1470x1137
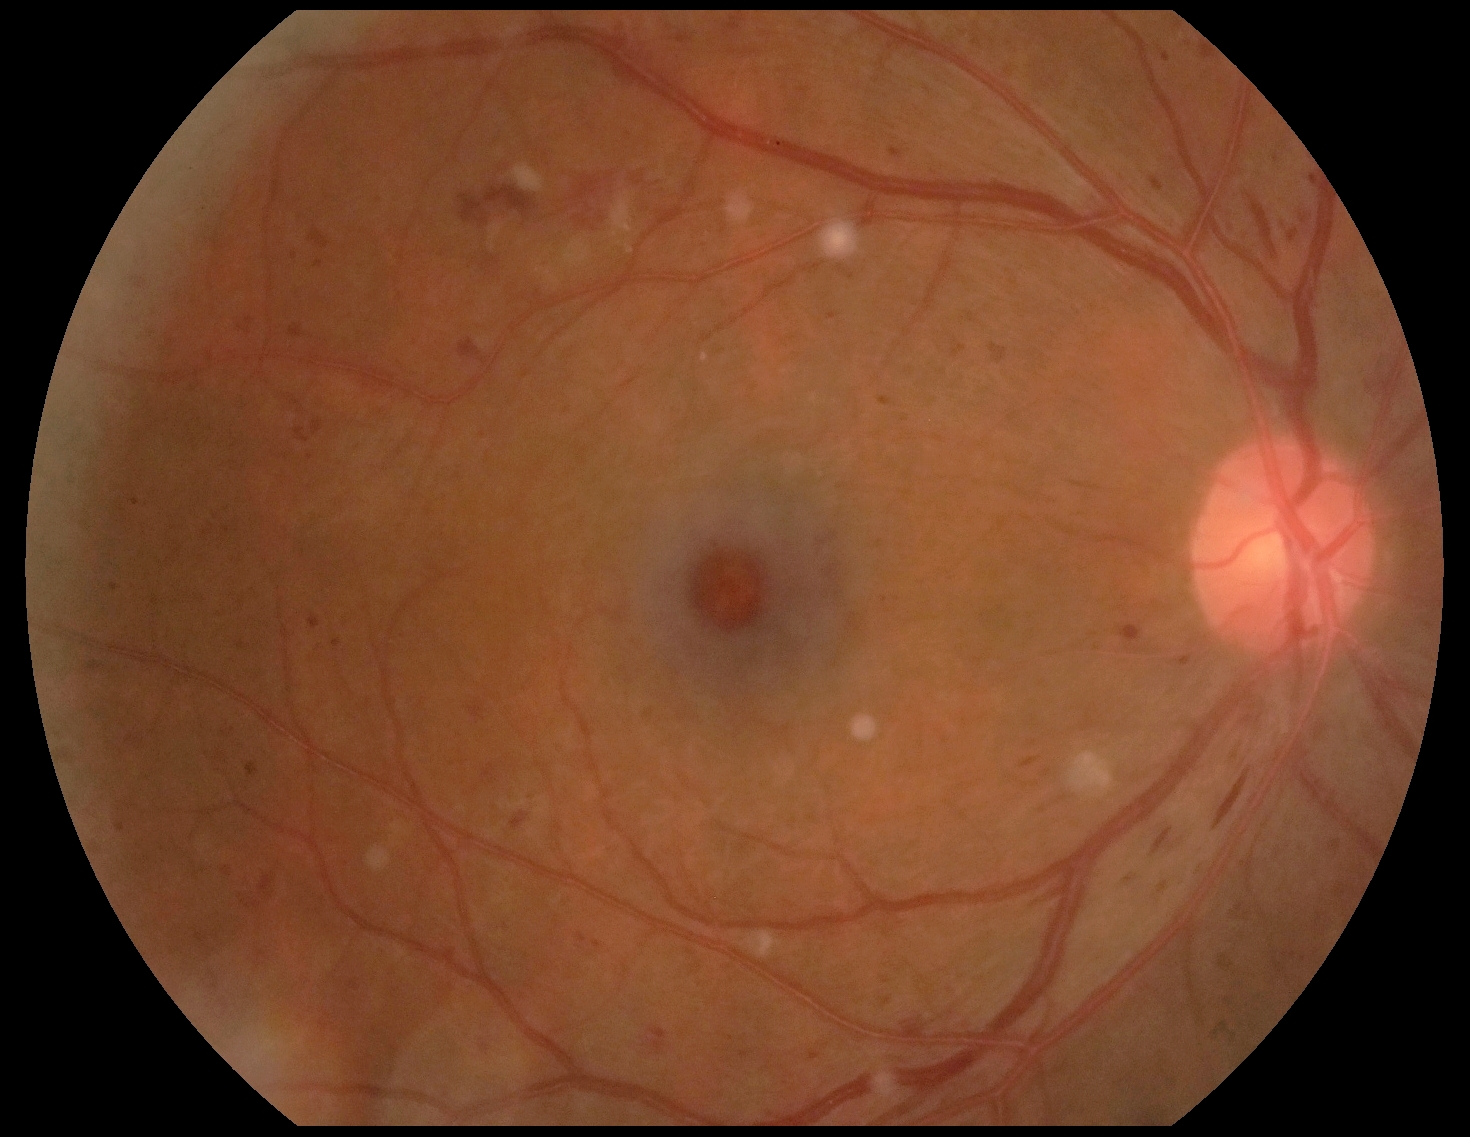

Diabetic retinopathy grade: severe NPDR (3) — more than 20 intraretinal hemorrhages in each of 4 quadrants, definite venous beading in 2 or more quadrants, or prominent intraretinal microvascular abnormalities in 1 or more quadrants, with no signs of proliferative retinopathy.